45° field of view · graded on the modified Davis scale · nonmydriatic fundus photograph · NIDEK AFC-230 — 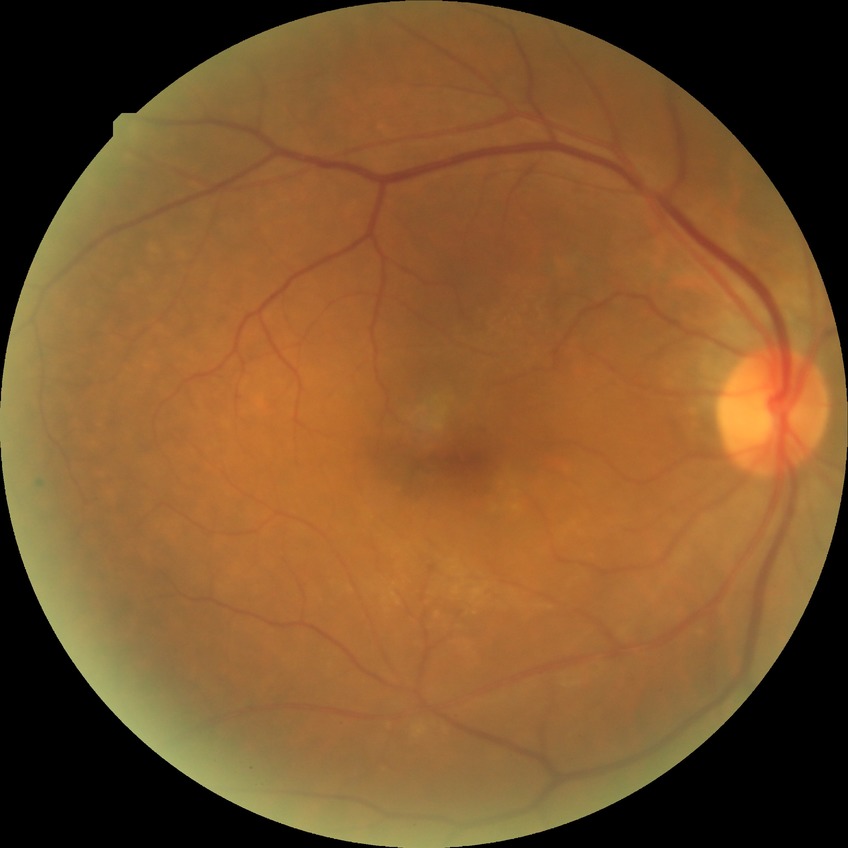

diabetic retinopathy (DR): no diabetic retinopathy (NDR).